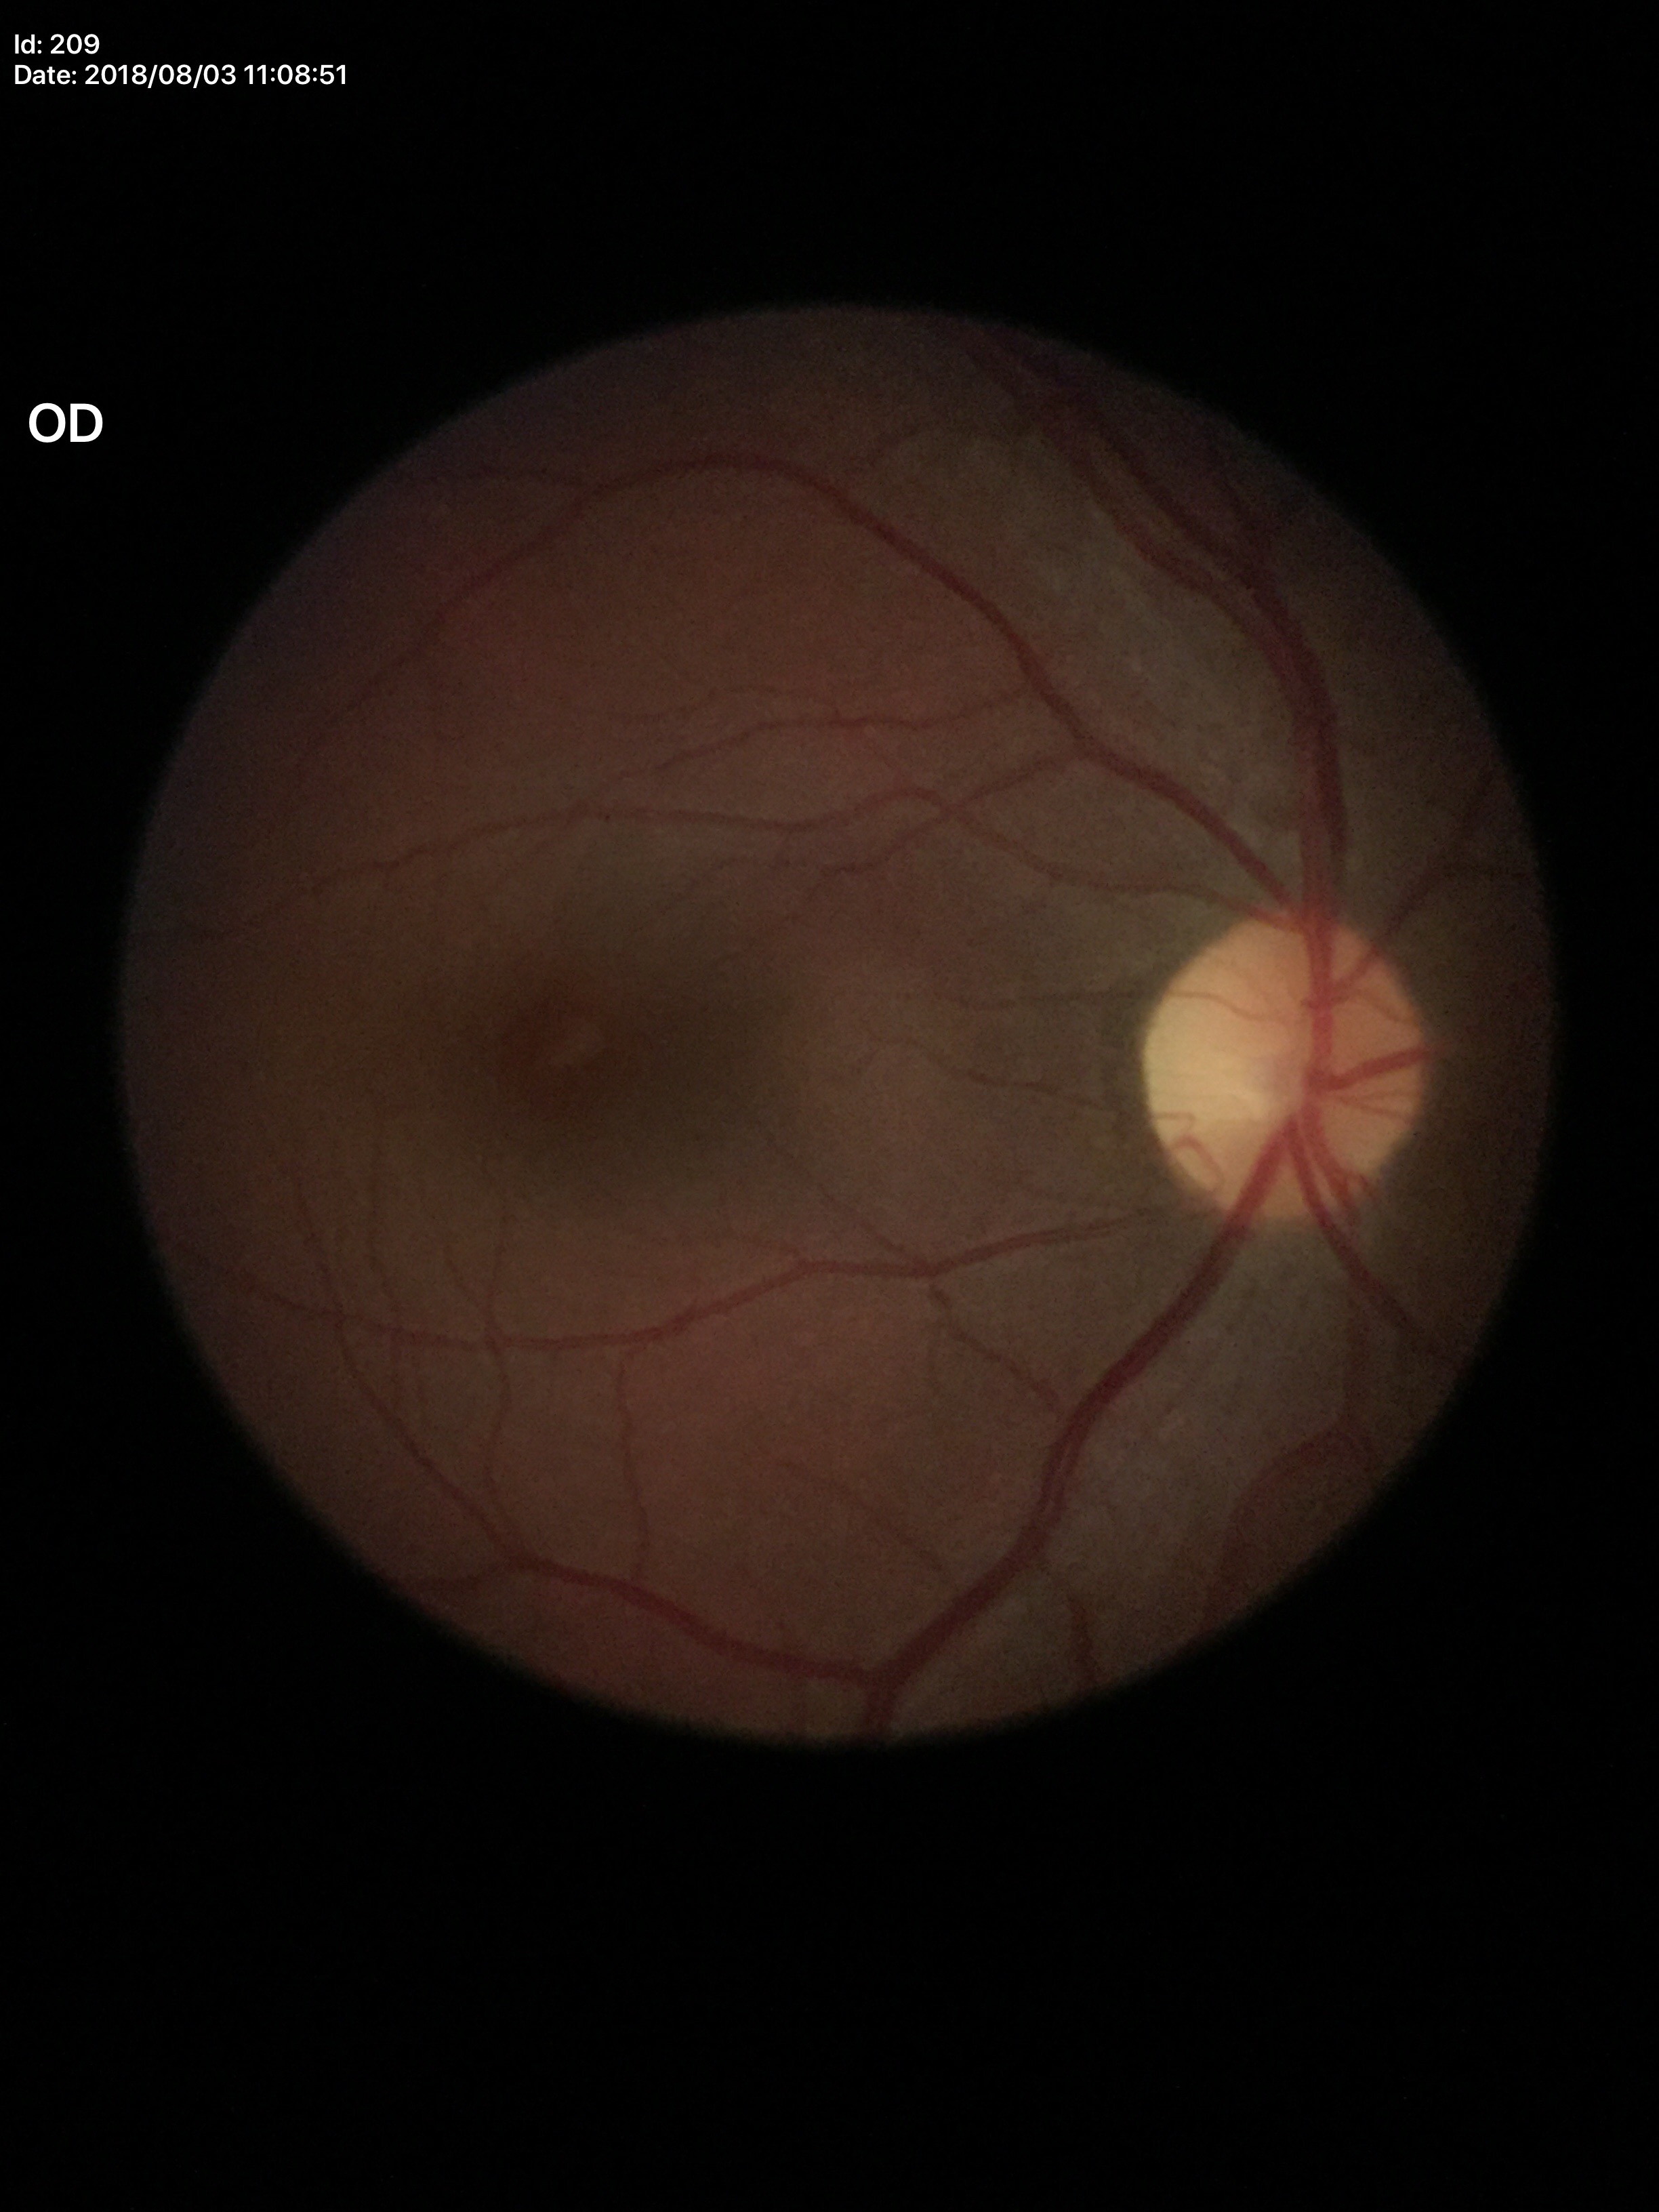 {"glaucoma_decision": "not suspect (unanimous normal call)", "vcdr": "0.41", "hcdr": "0.41"}